Image size 2048x1536 · CFP:
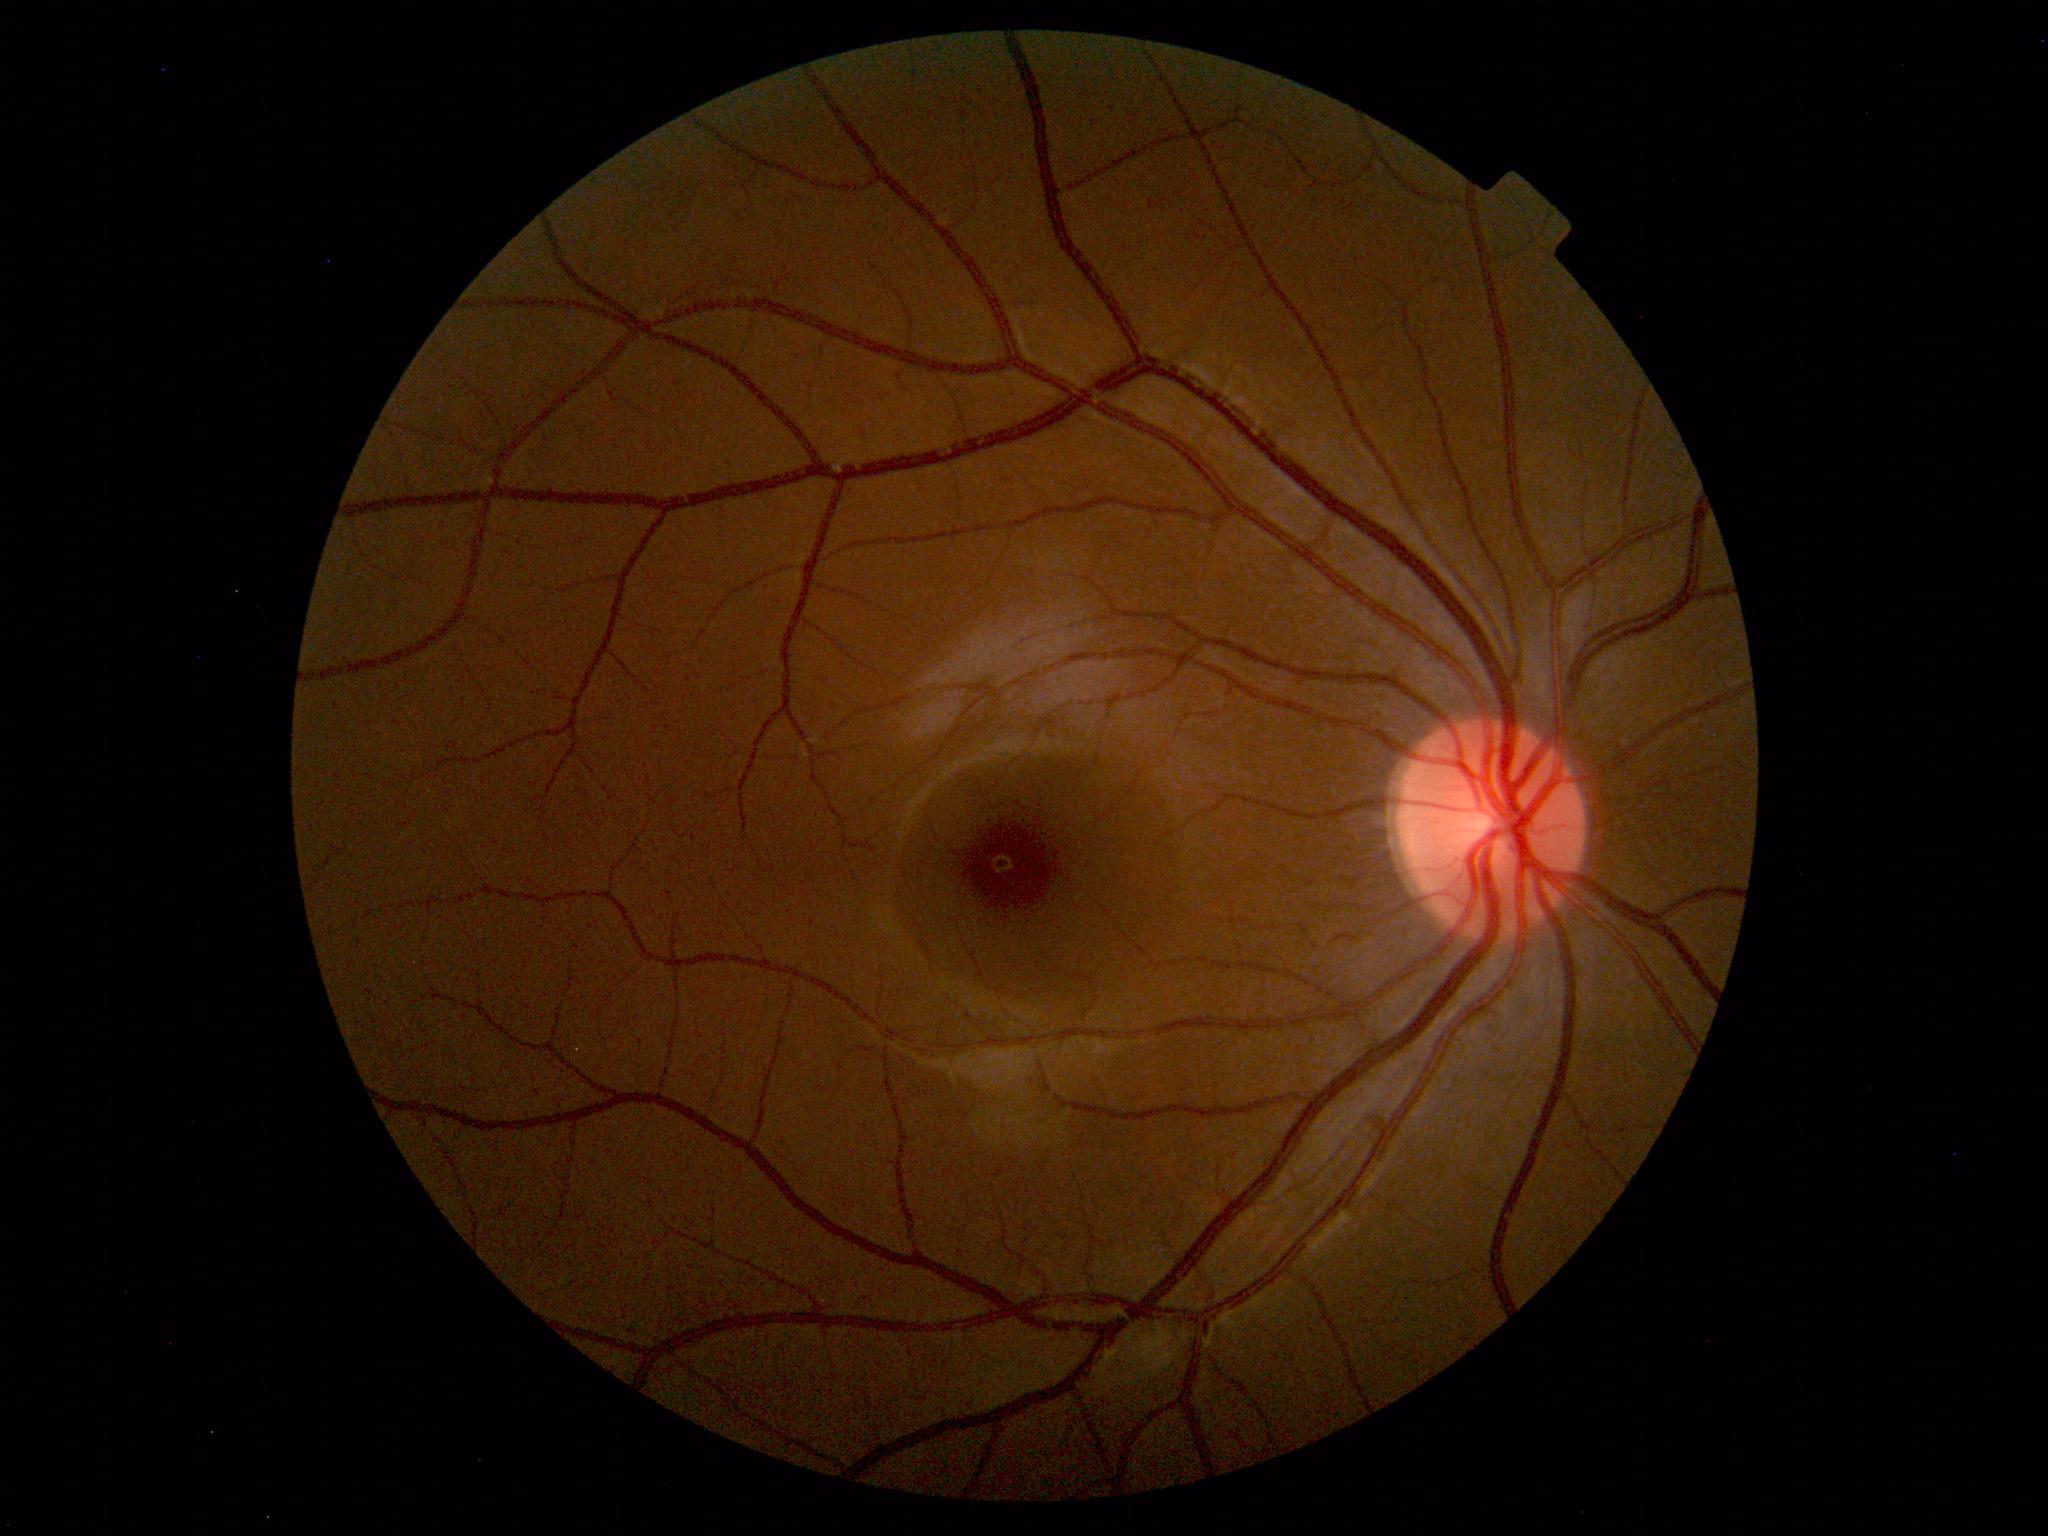

No retinal pathology identified.